1440 x 1080 pixels. Wide-field fundus image from infant ROP screening
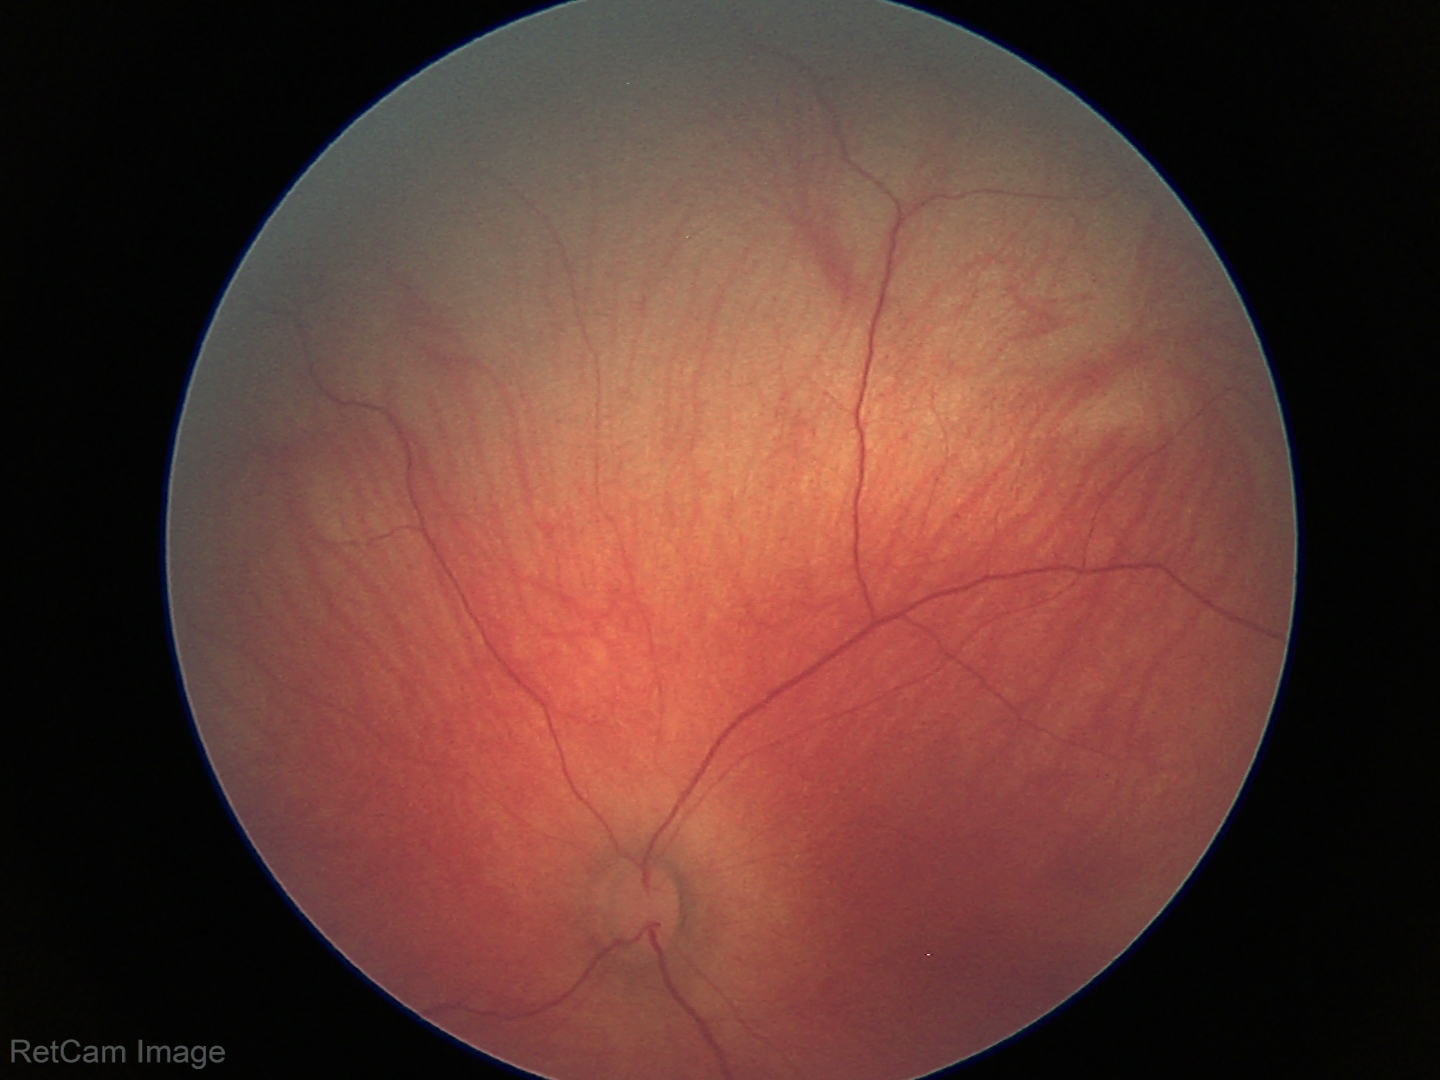
Normal screening examination.